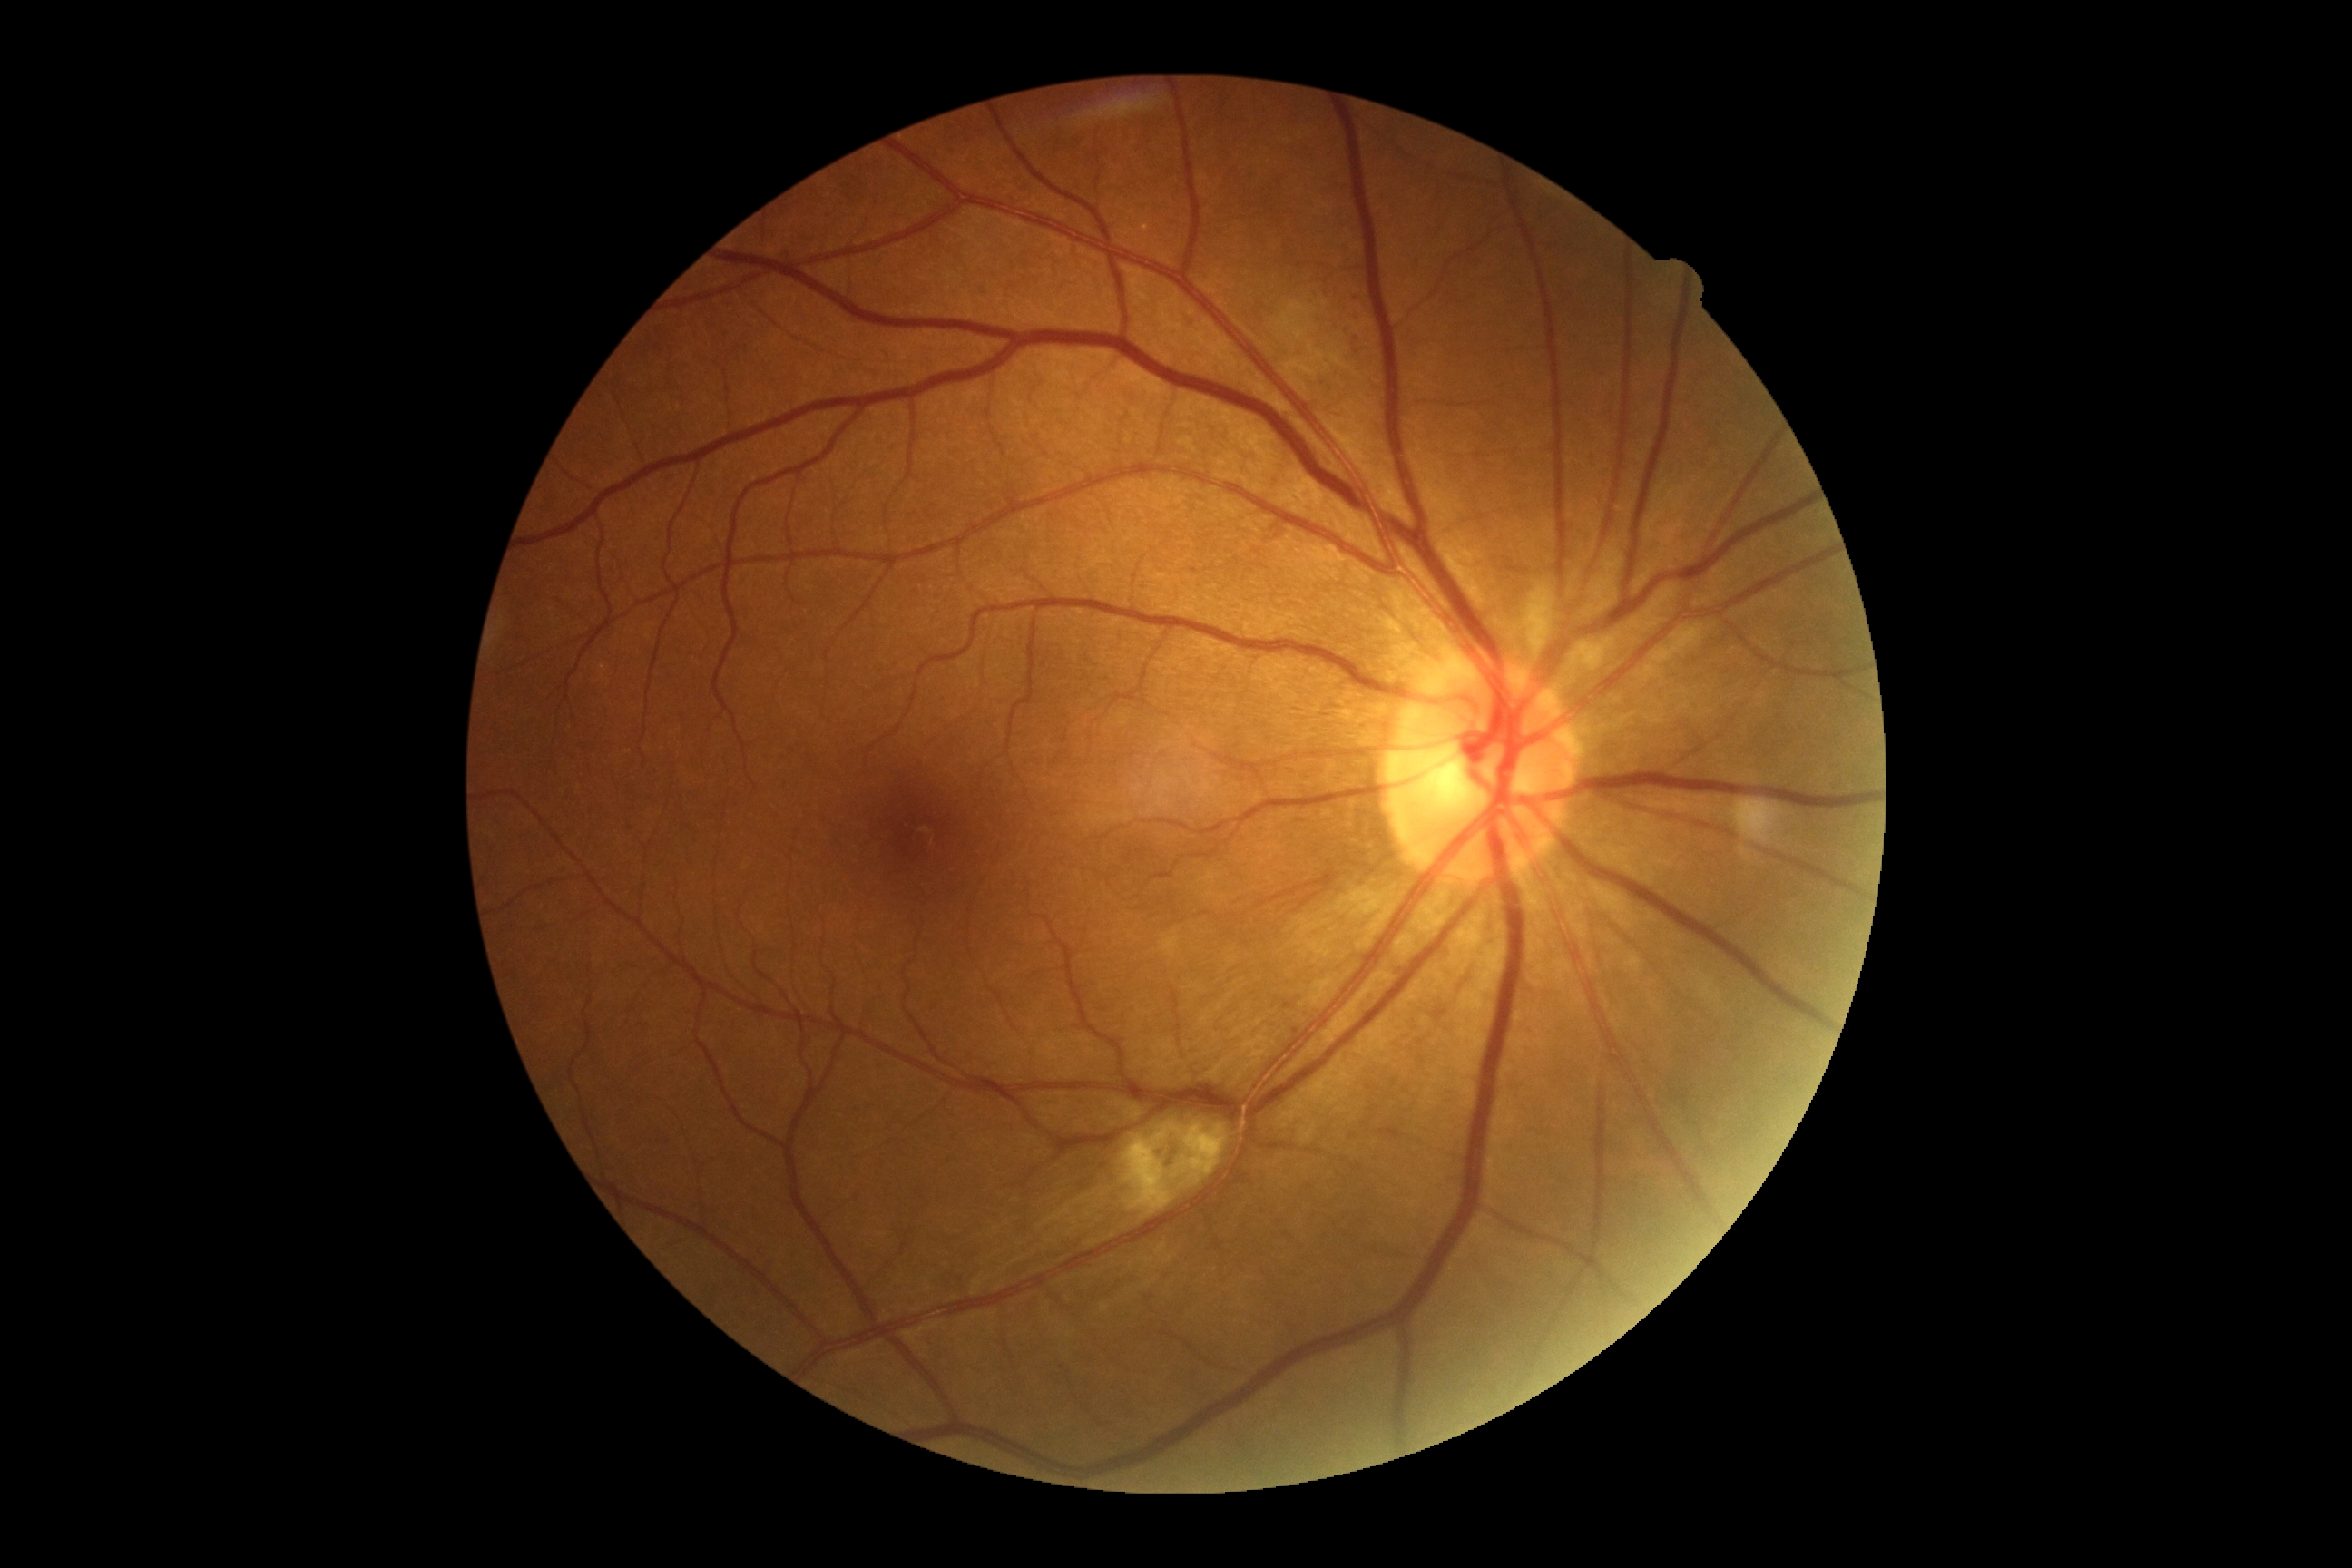
DR severity = moderate NPDR (grade 2).